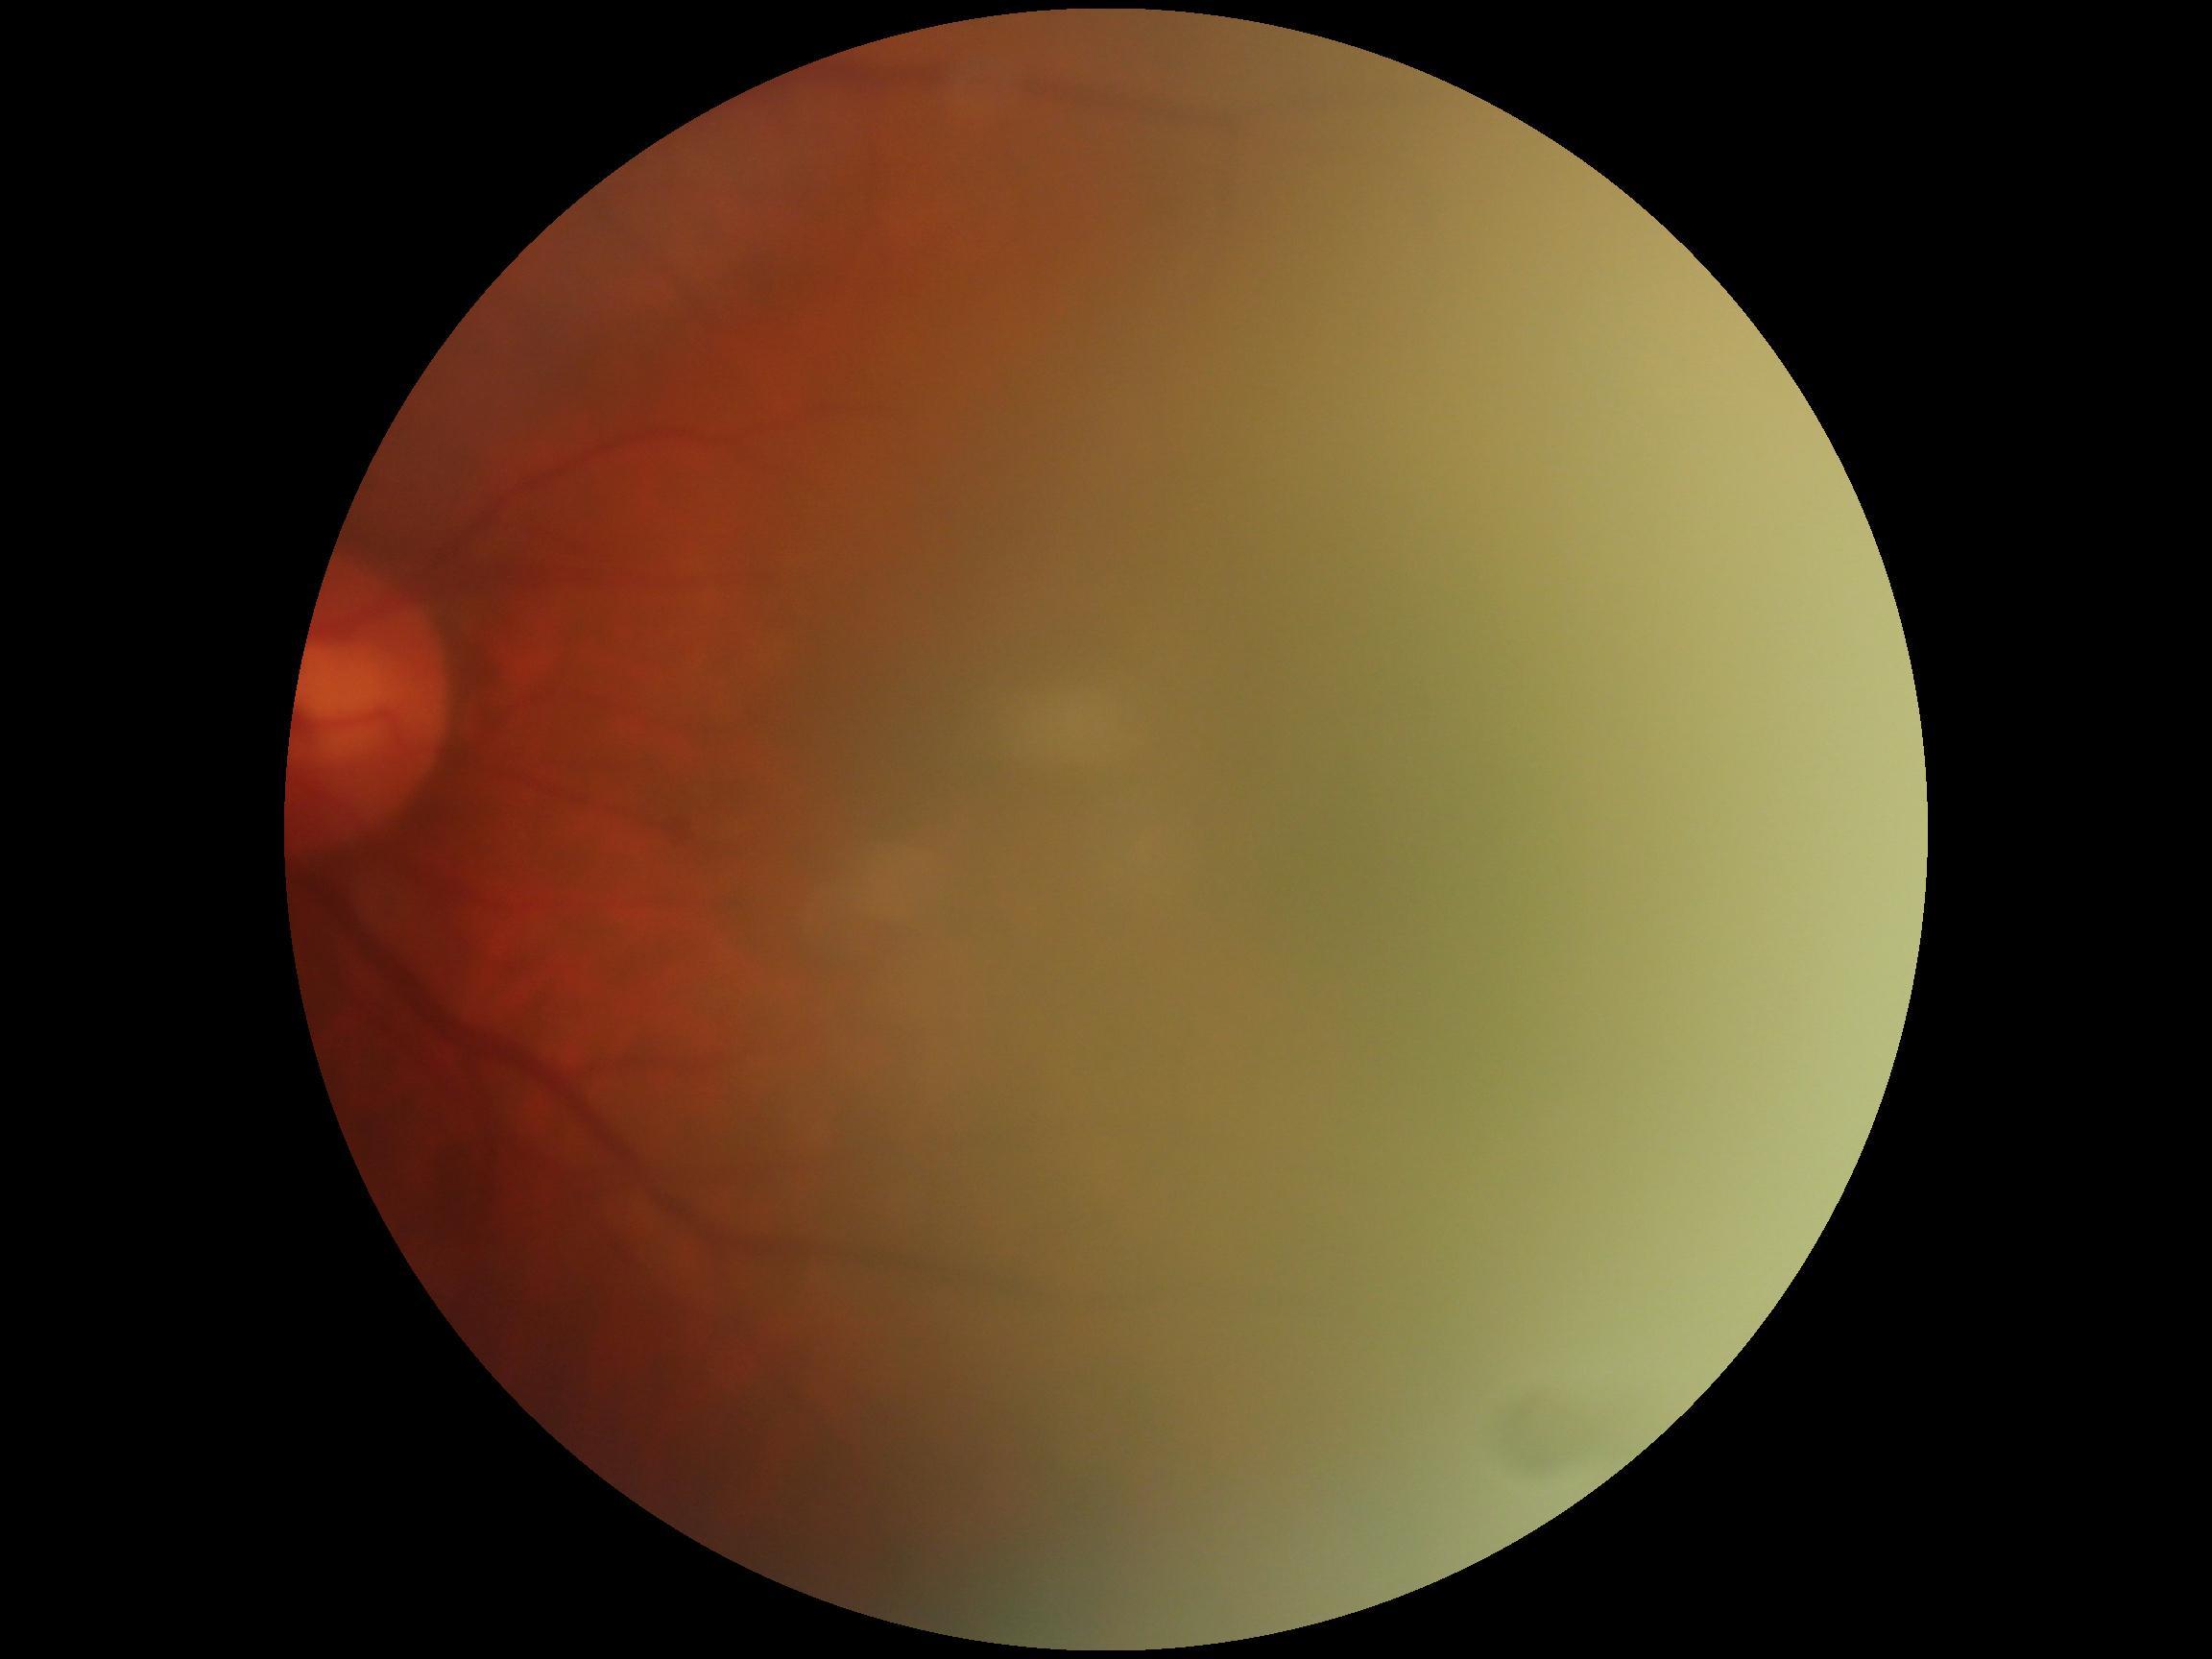

DR stage = ungradable due to poor image quality, image quality = too poor for DR grading.